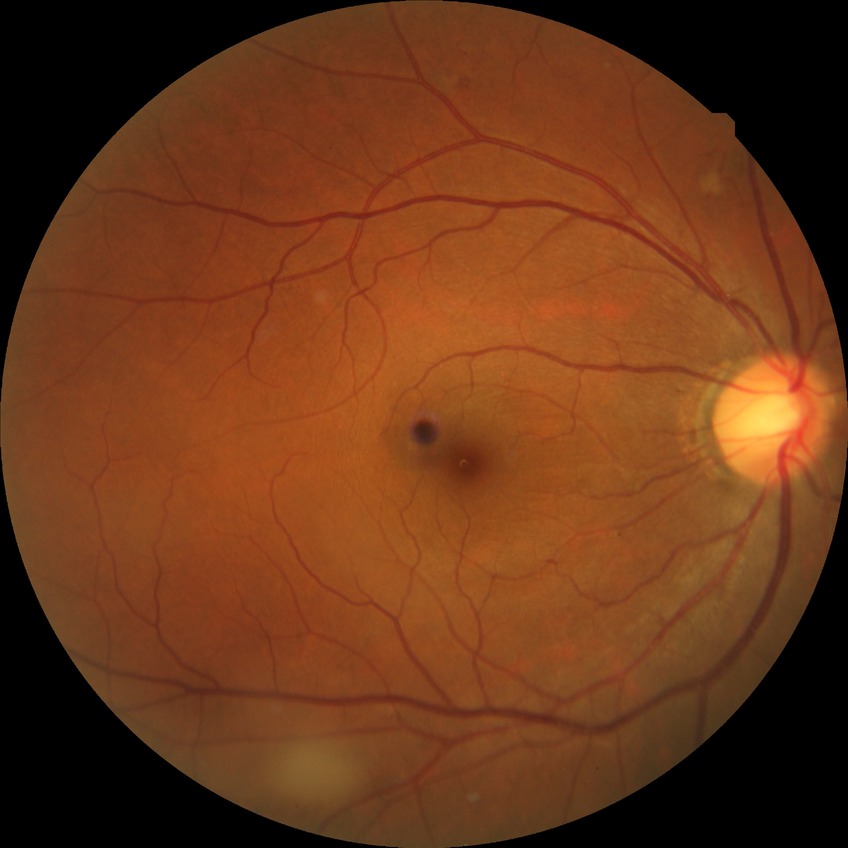

Diabetic retinopathy severity is simple diabetic retinopathy.